Wide-field fundus photograph from neonatal ROP screening · 640x480px: 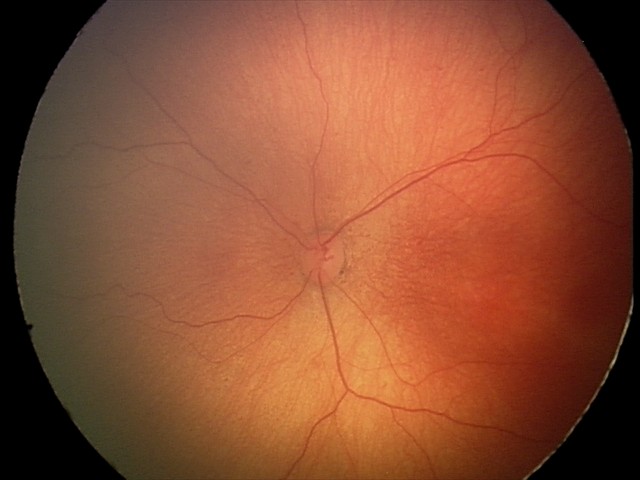

Screening: ROP stage 1; no plus disease — posterior pole vessels without abnormal dilation or tortuosity.